Davis DR grading, 848 by 848 pixels
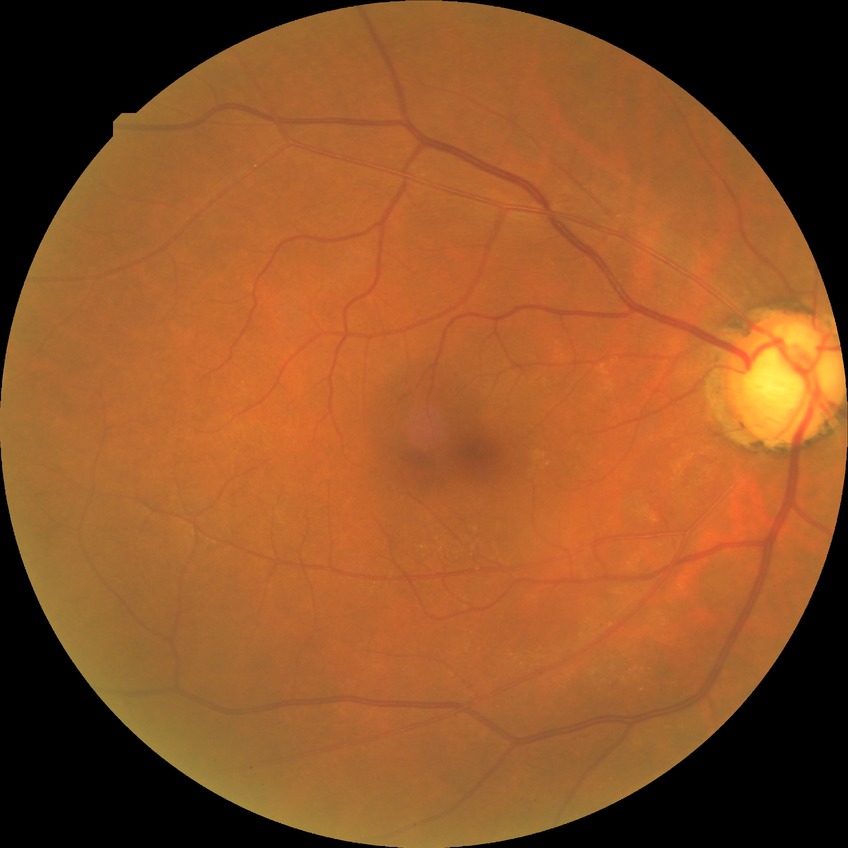
diabetic retinopathy severity = no diabetic retinopathy.